2352 x 1568 pixels · color fundus image — 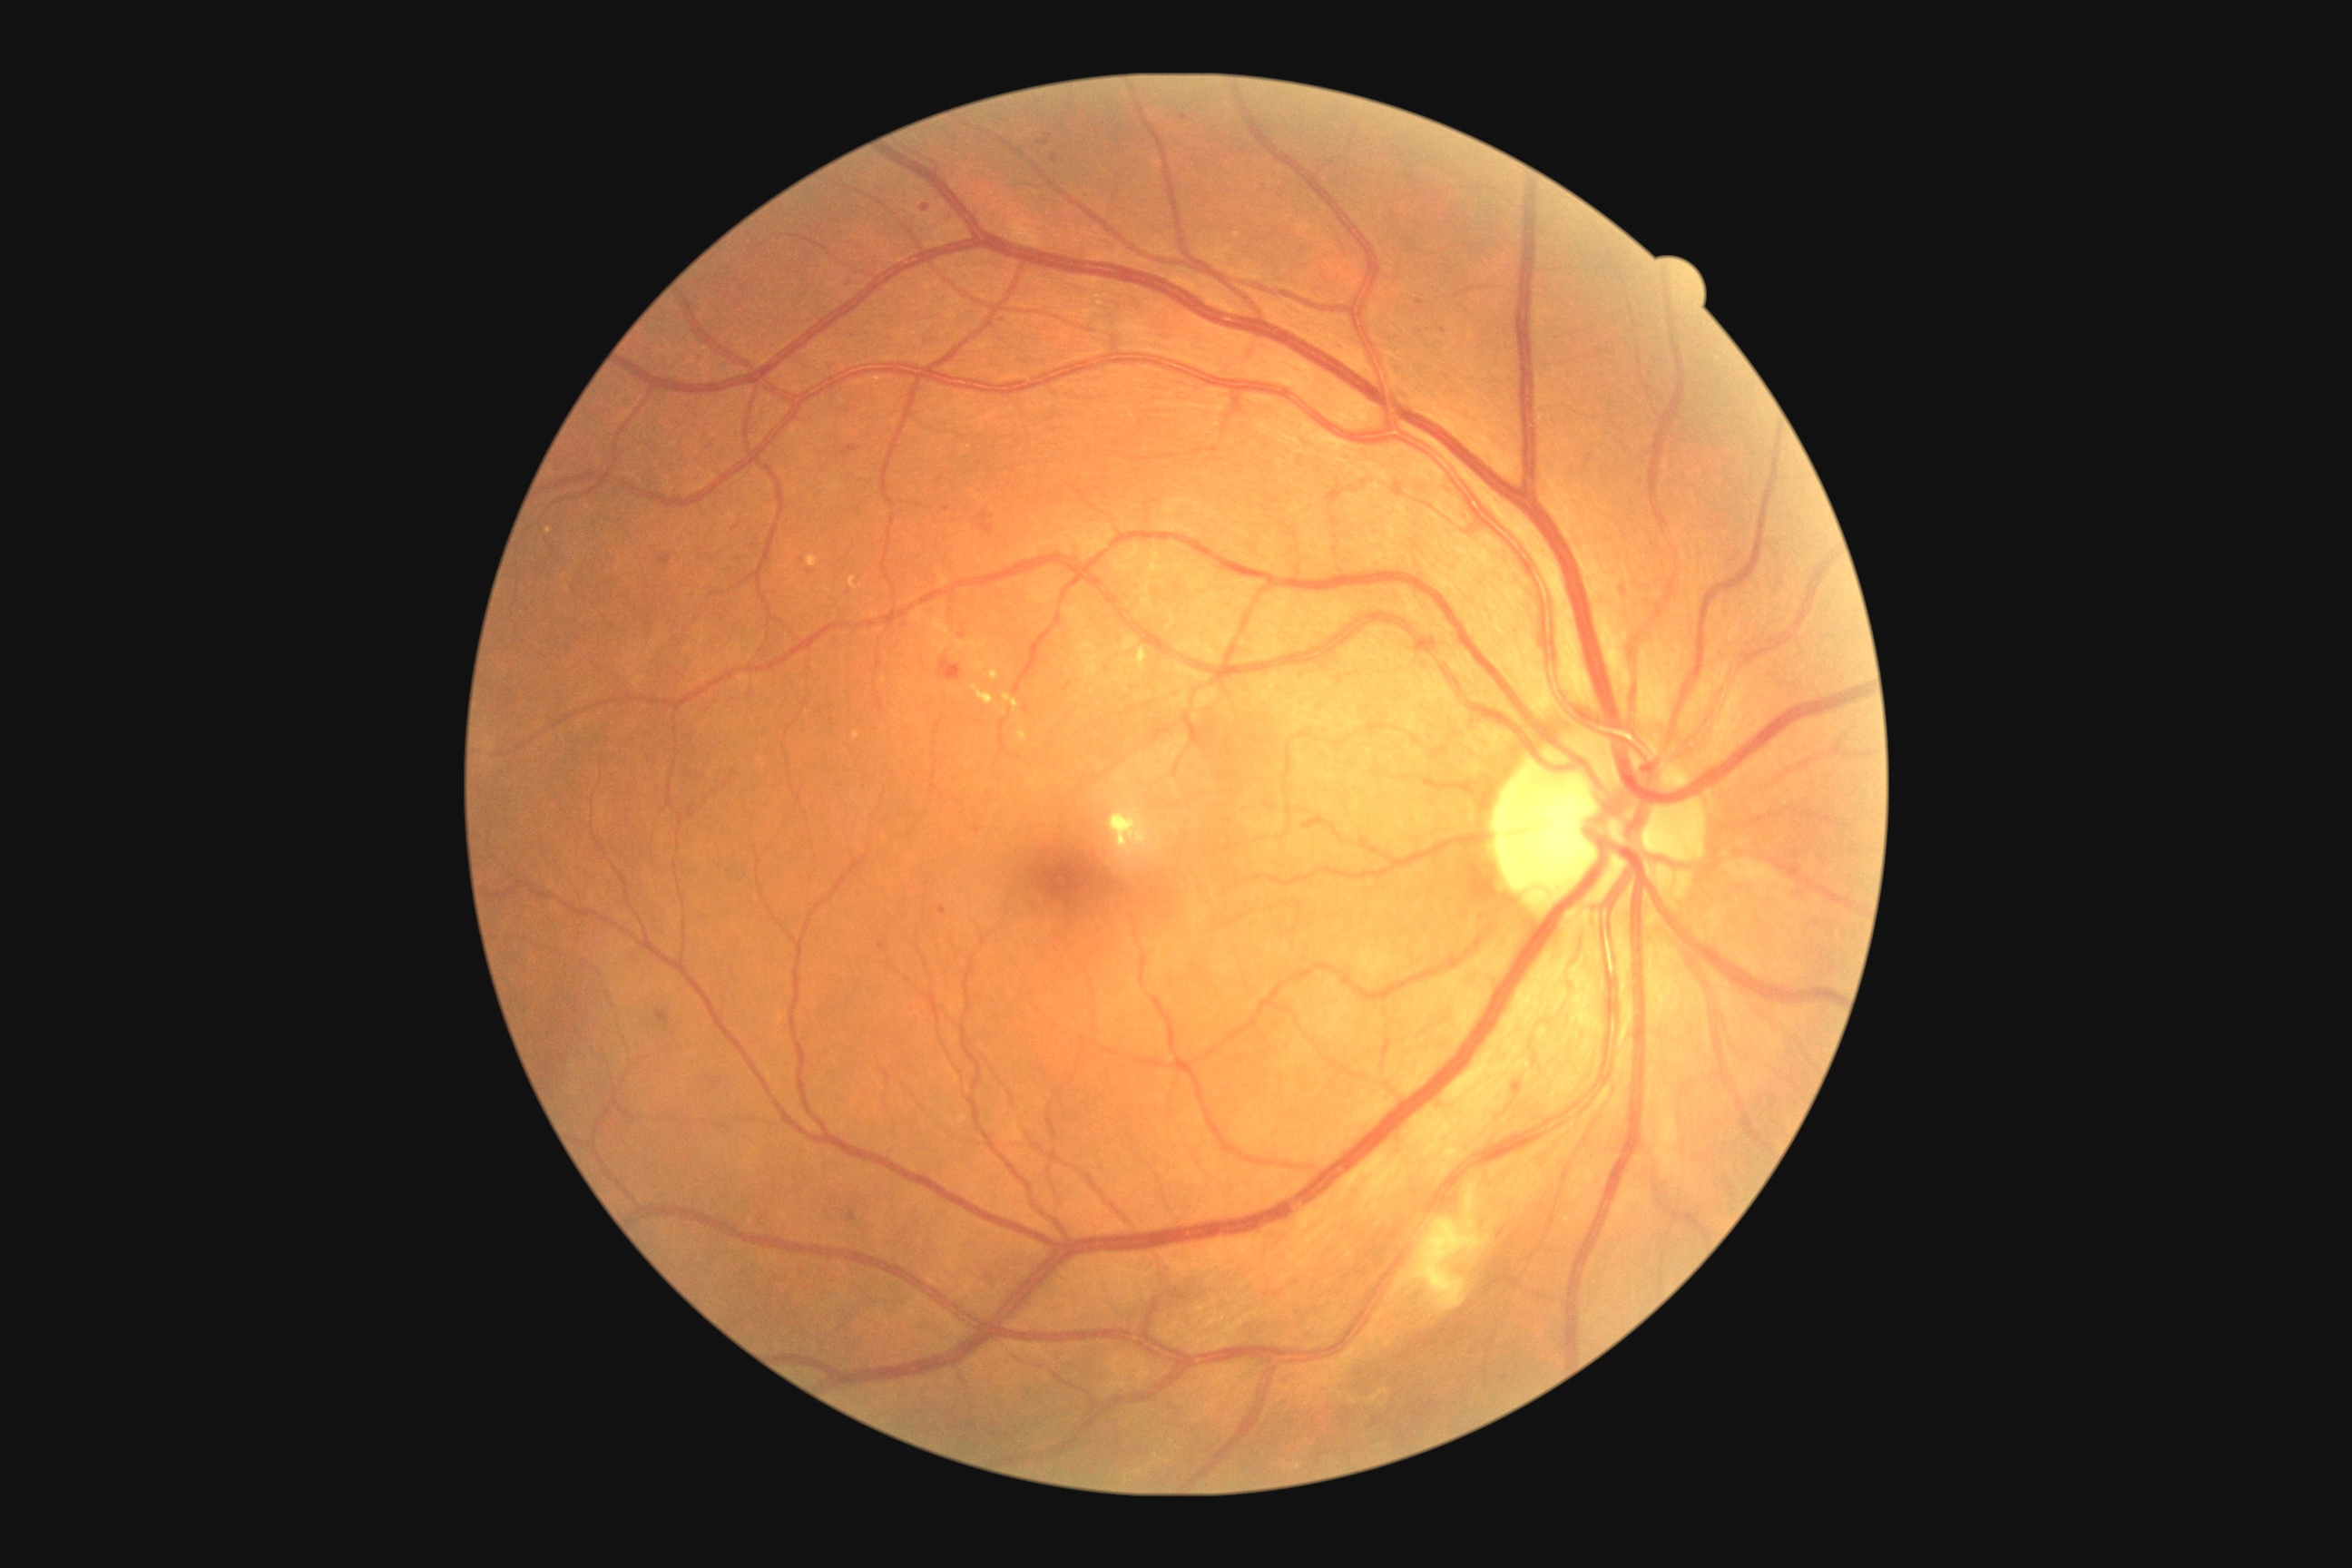 Retinopathy: 2; non-proliferative diabetic retinopathy
A subset of detected lesions:
microaneurysms (continued): [660, 556, 671, 565]; [1039, 133, 1052, 146]; [943, 507, 952, 513]; [879, 943, 887, 950]; [850, 1211, 858, 1220]; [656, 1010, 671, 1024]; [1416, 300, 1424, 306]
Small microaneurysms near (978; 831); (1298; 373); (1815; 923); (1443; 330); (1340; 348)